Fundus photo · 45° FOV:
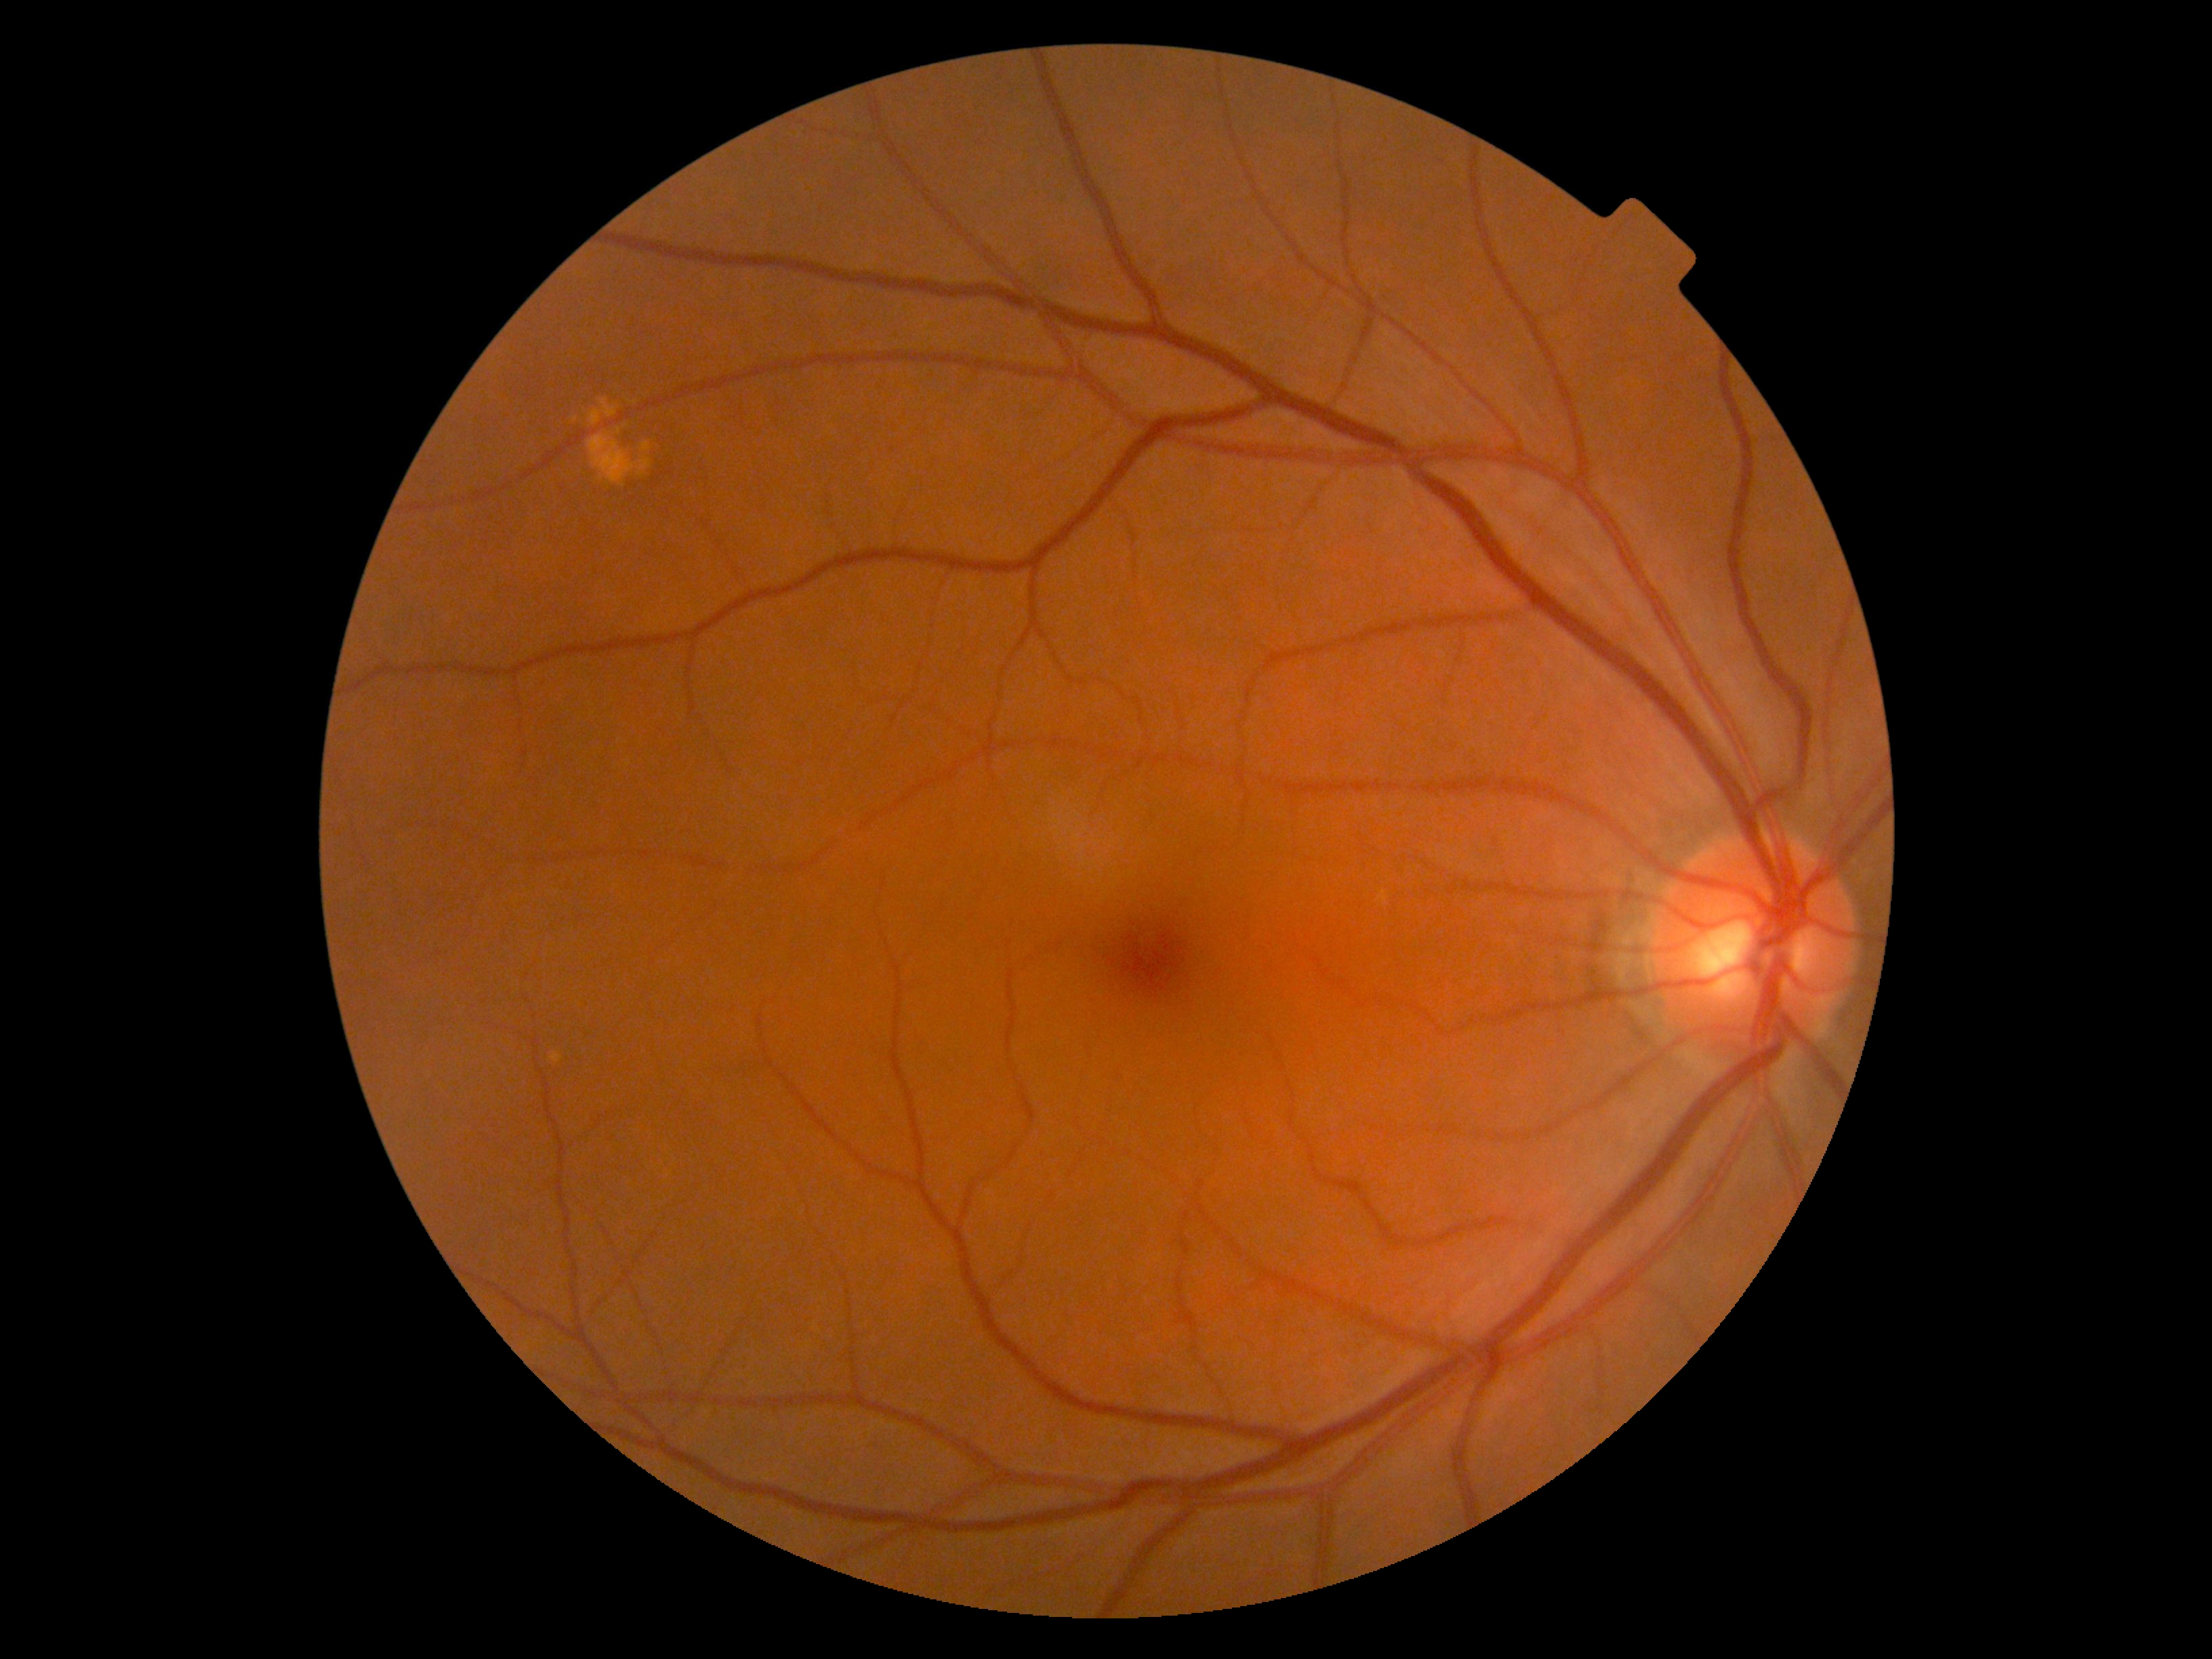

Annotations:
- DR — no apparent retinopathy (grade 0)